NIDEK AFC-230; fundus photo; image size 848x848; nonmydriatic fundus photograph; FOV: 45 degrees:
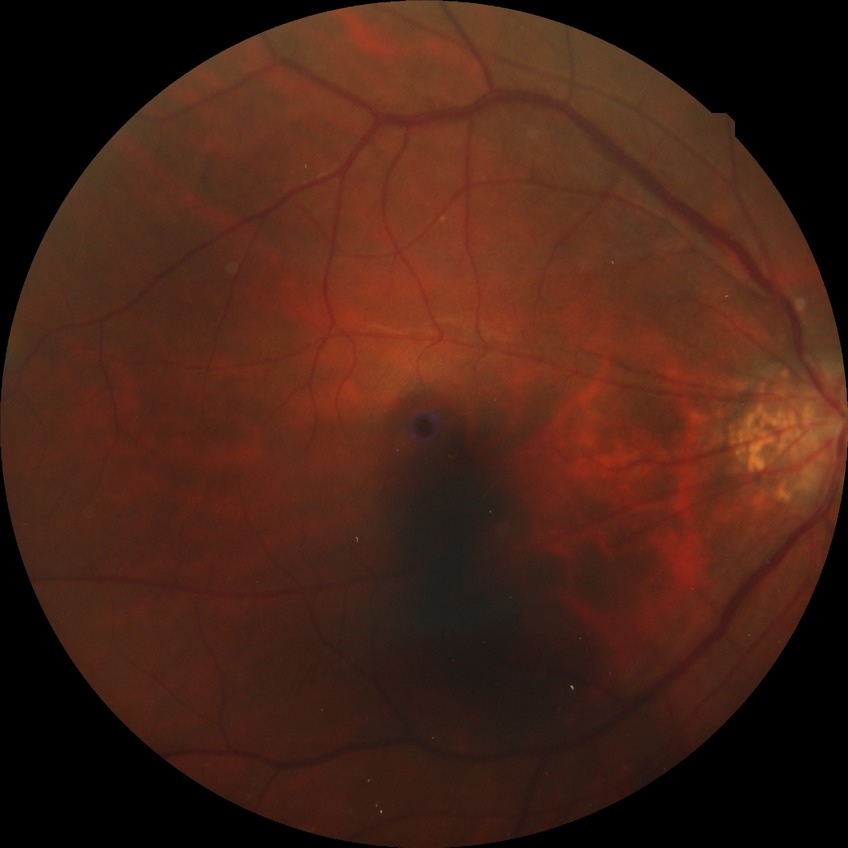

diabetic retinopathy (DR) = NDR (no diabetic retinopathy)